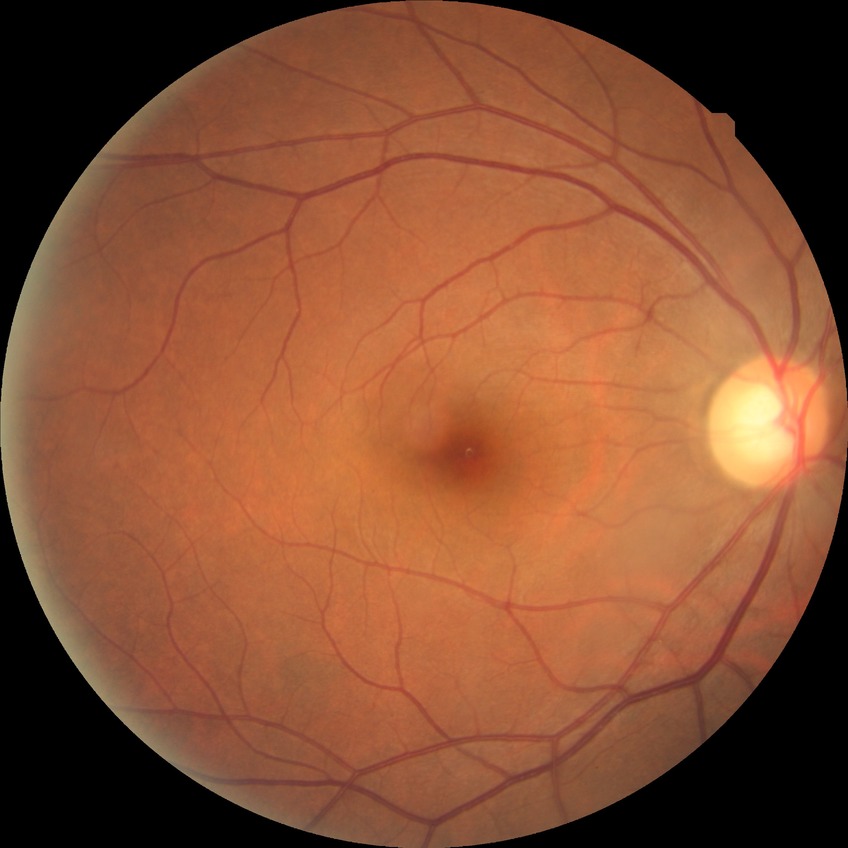 Davis grade = NDR.